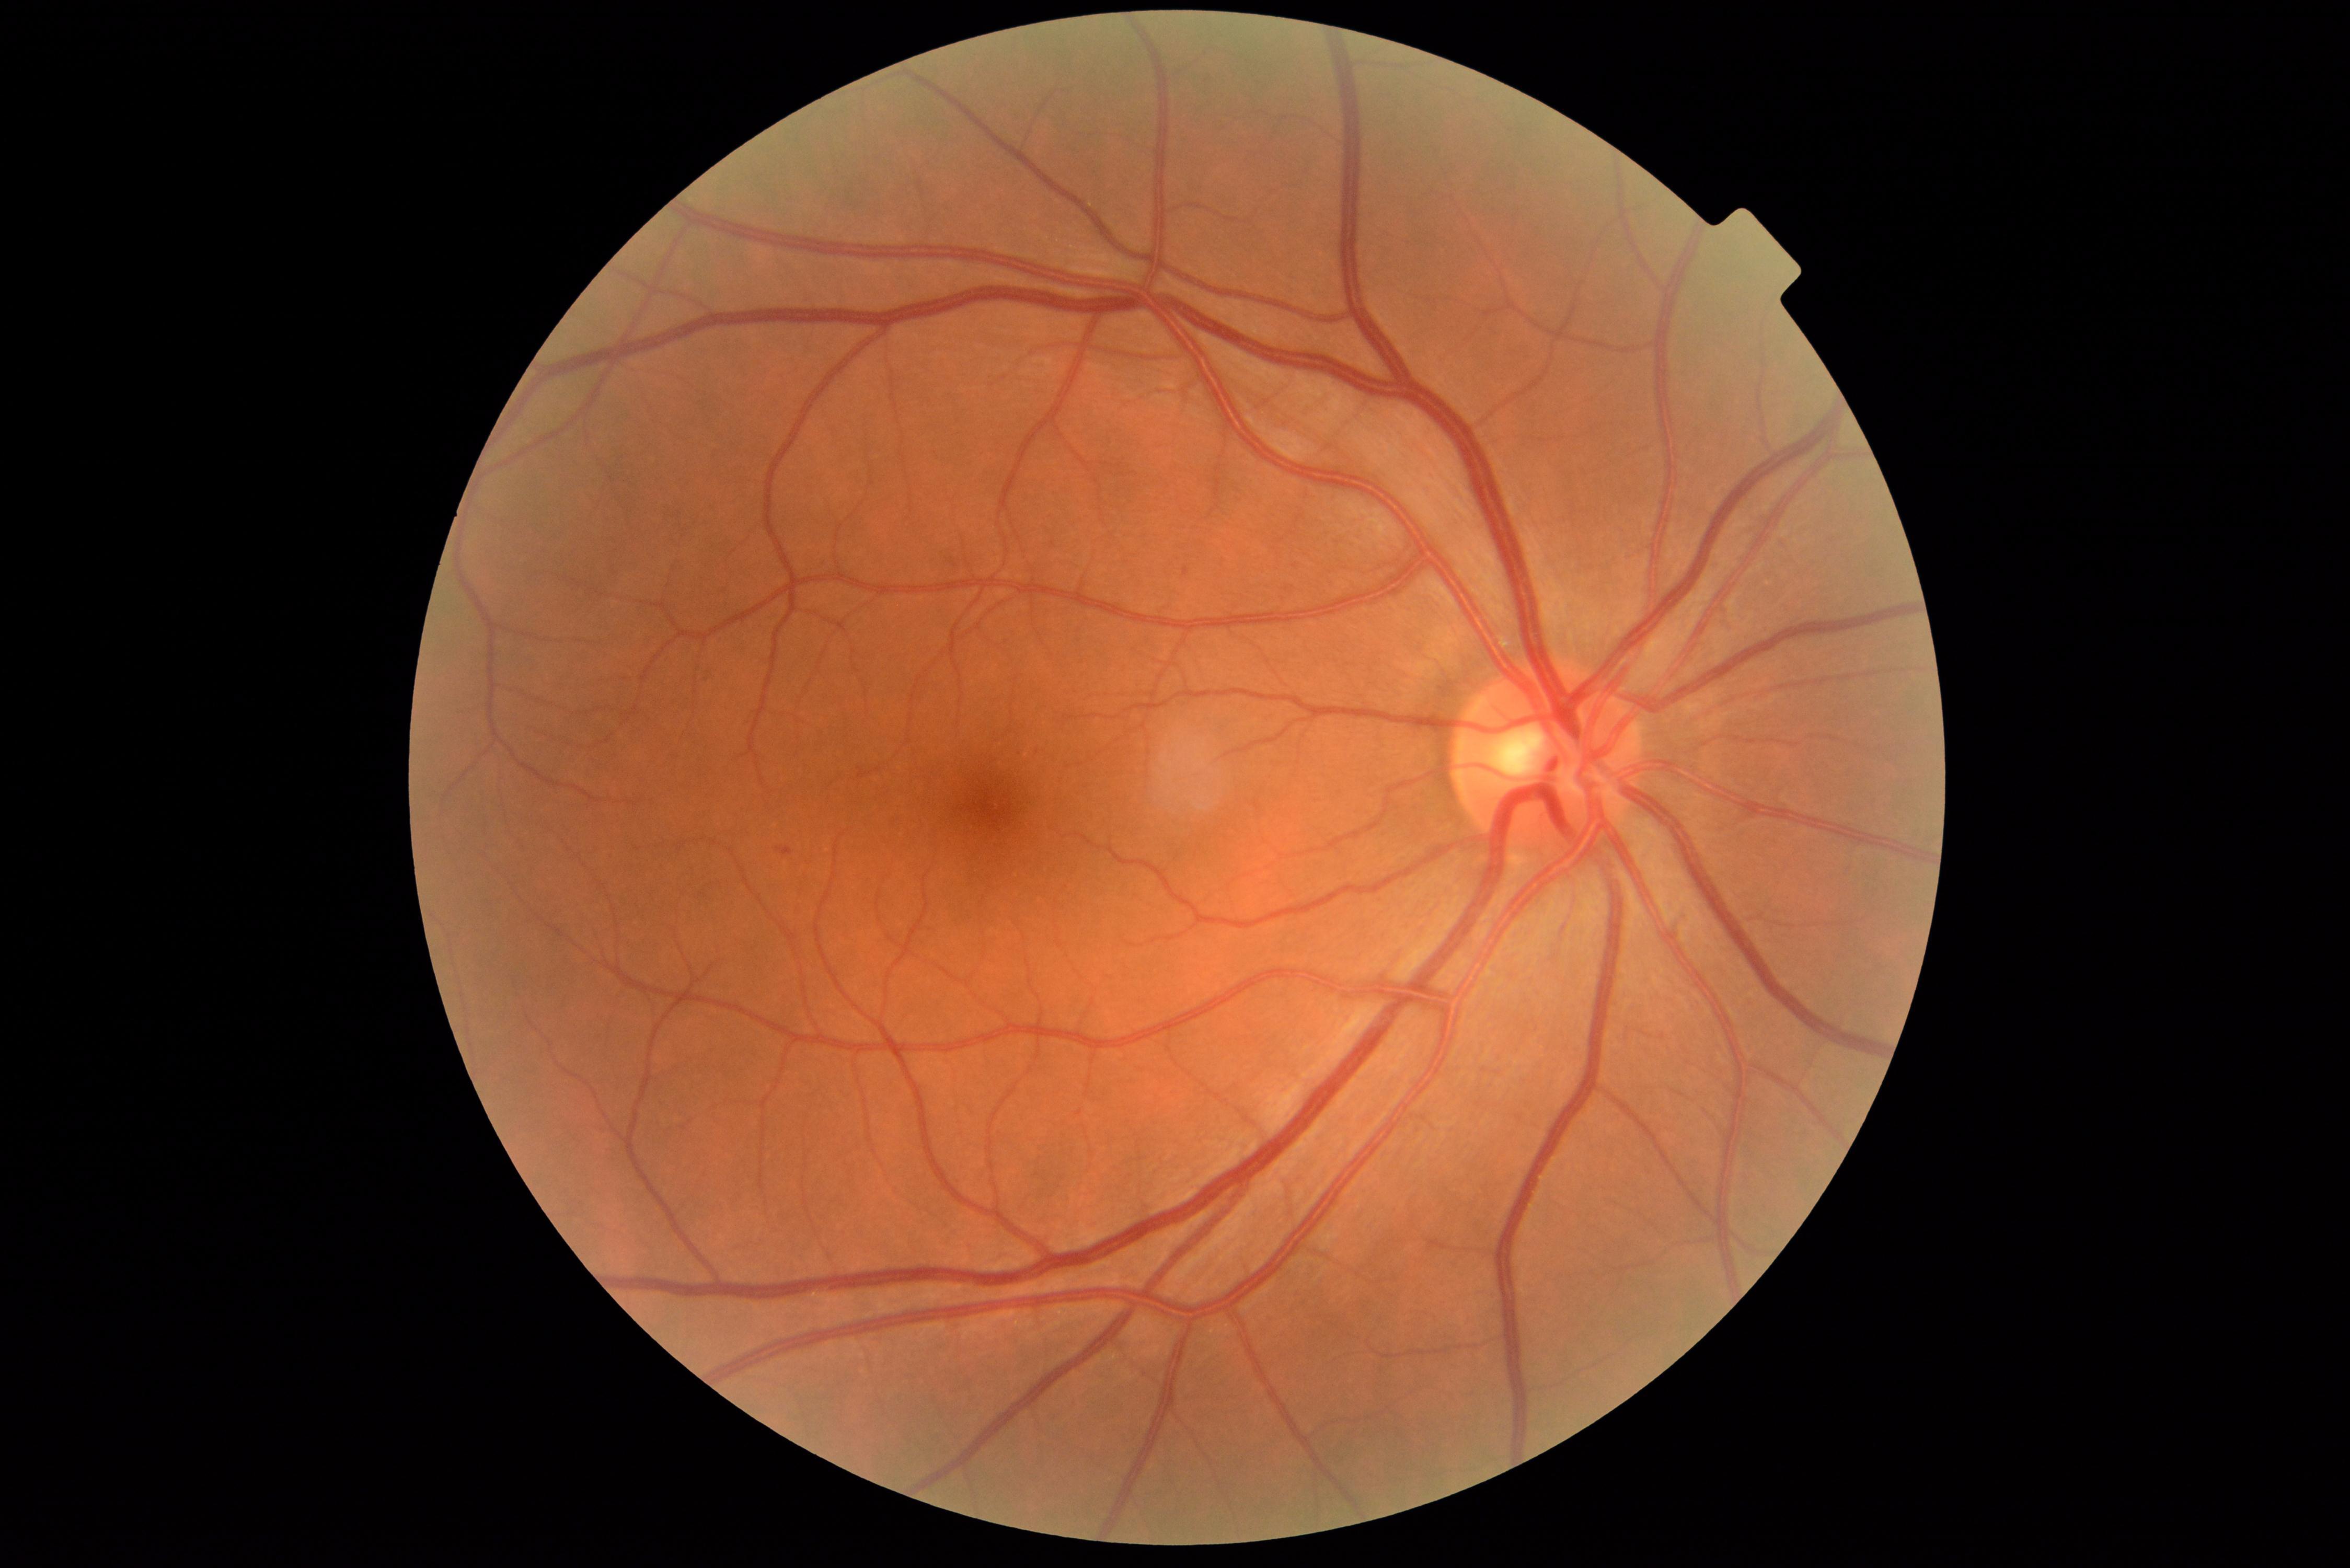
Diabetic retinopathy (DR): 1
• hard exudates (EXs): not present
• hemorrhages (HEs): not present
• microaneurysms (MAs): BBox(1184, 568, 1189, 578); BBox(781, 846, 790, 856)
• soft exudates (SEs): not present